Retinal fundus photograph · nonmydriatic · NIDEK AFC-230 · 45° FOV · image size 848x848 · diabetic retinopathy graded by the modified Davis classification.
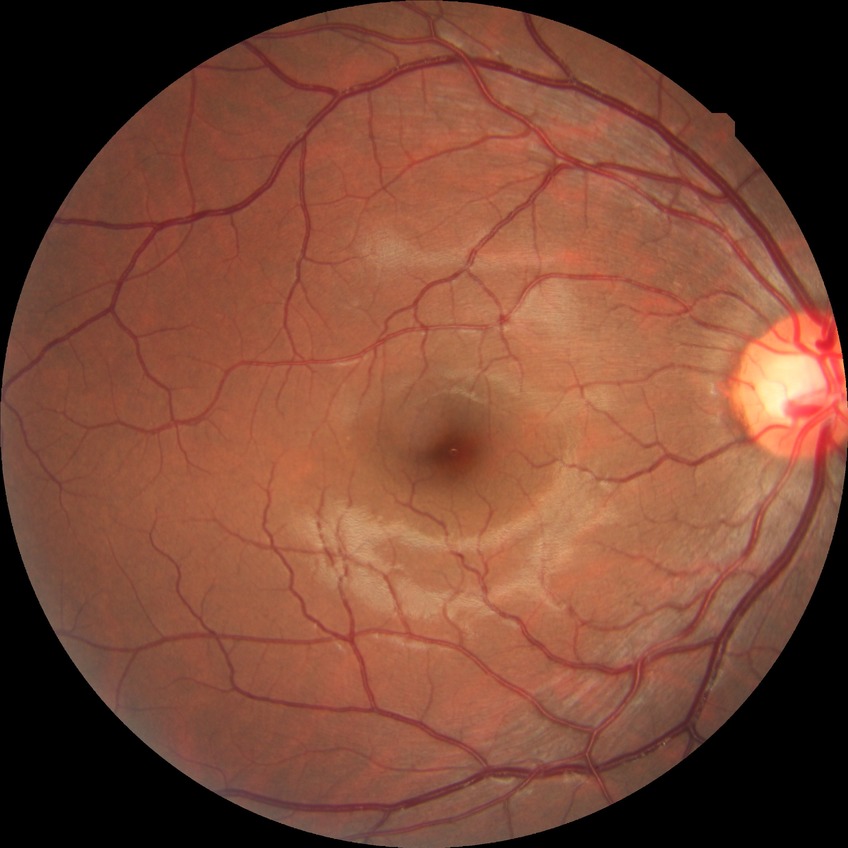

Diabetic retinopathy (DR) is no diabetic retinopathy (NDR).